Graded on the modified Davis scale:
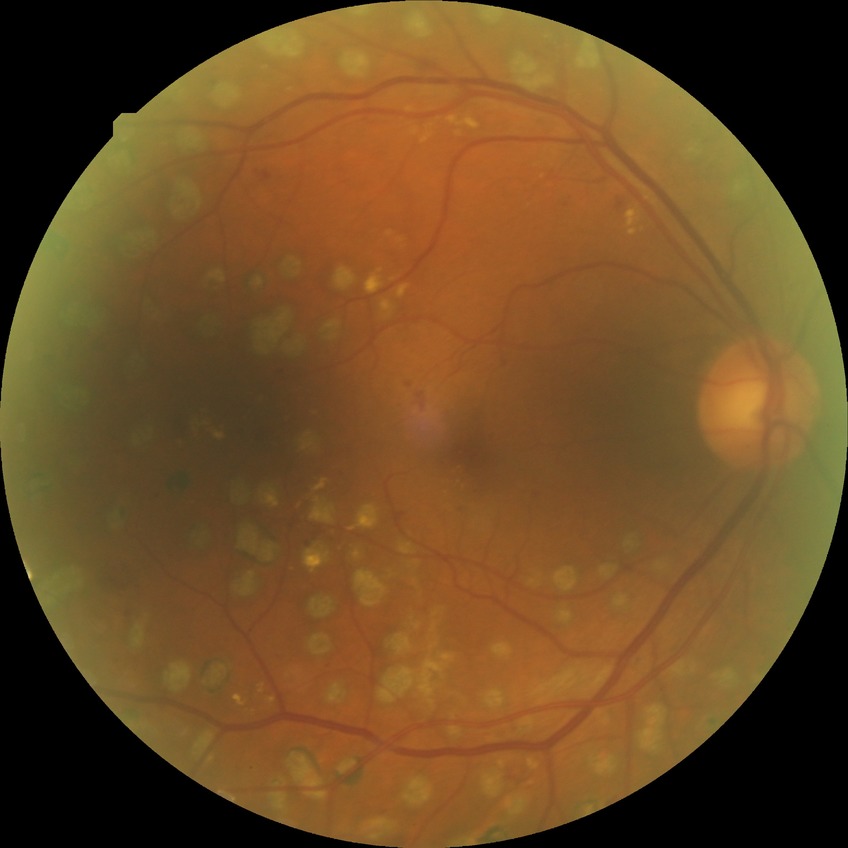

Diabetic retinopathy (DR): PDR (proliferative diabetic retinopathy).